45° field of view:
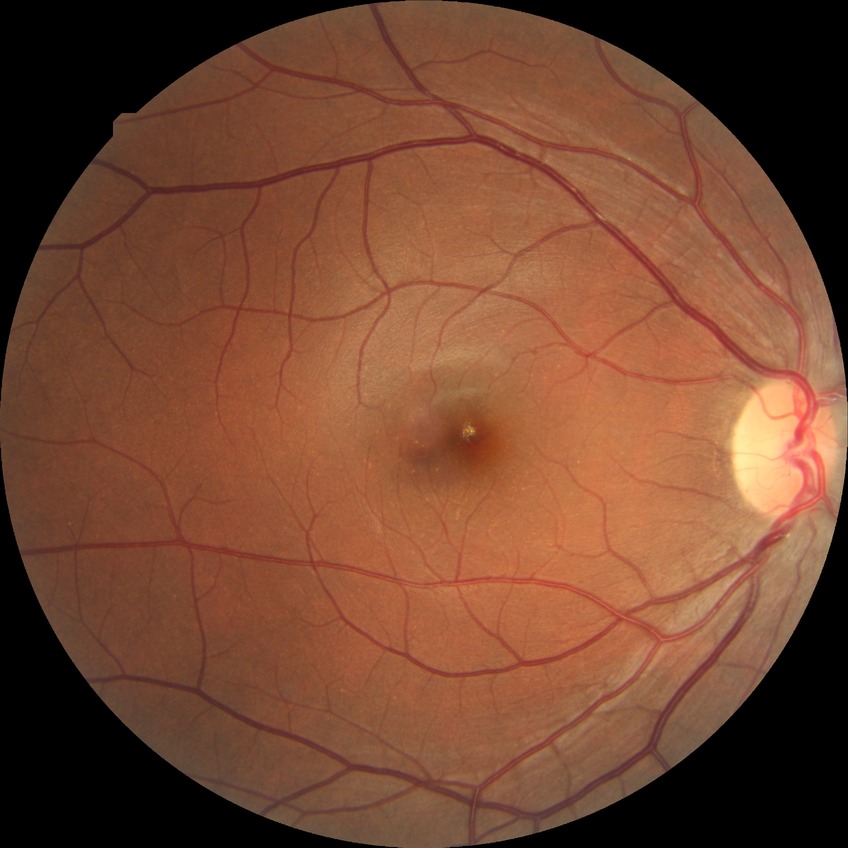 davis_grade: no diabetic retinopathy